Retinal fundus photograph — 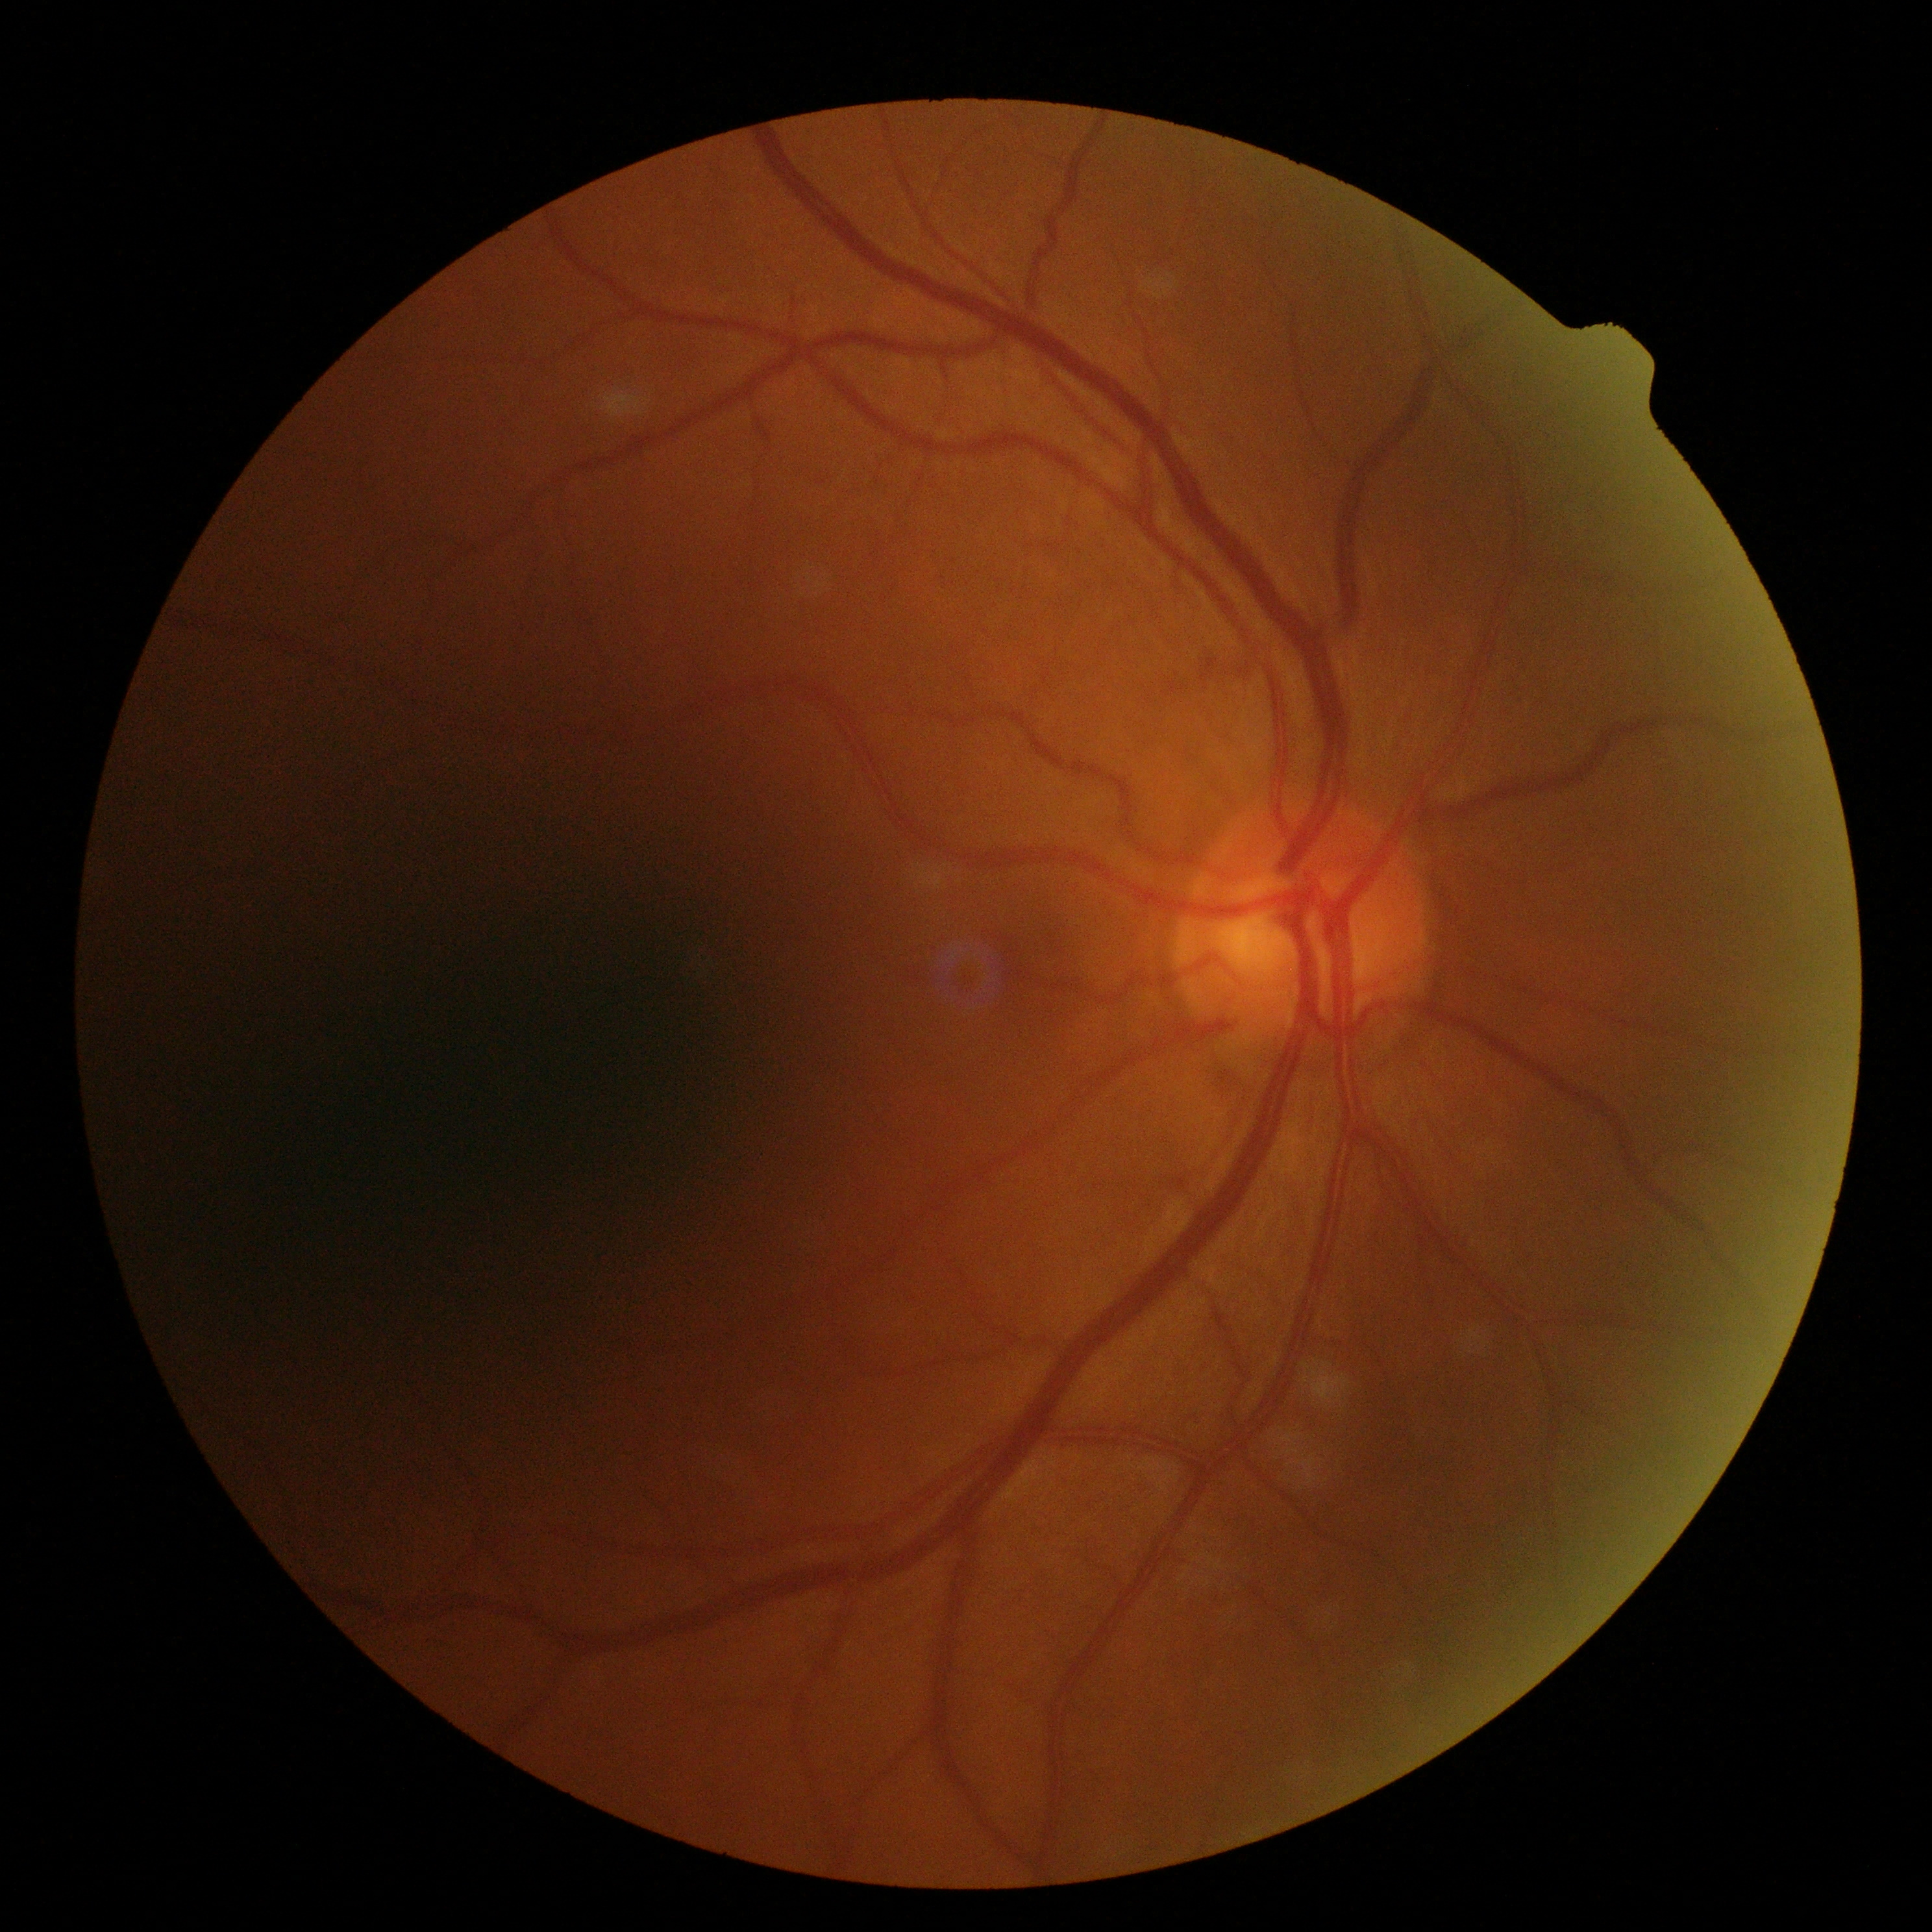 Diabetic retinopathy severity: 0.